FOV: 45 degrees. Fundus photo. 1932x1923:
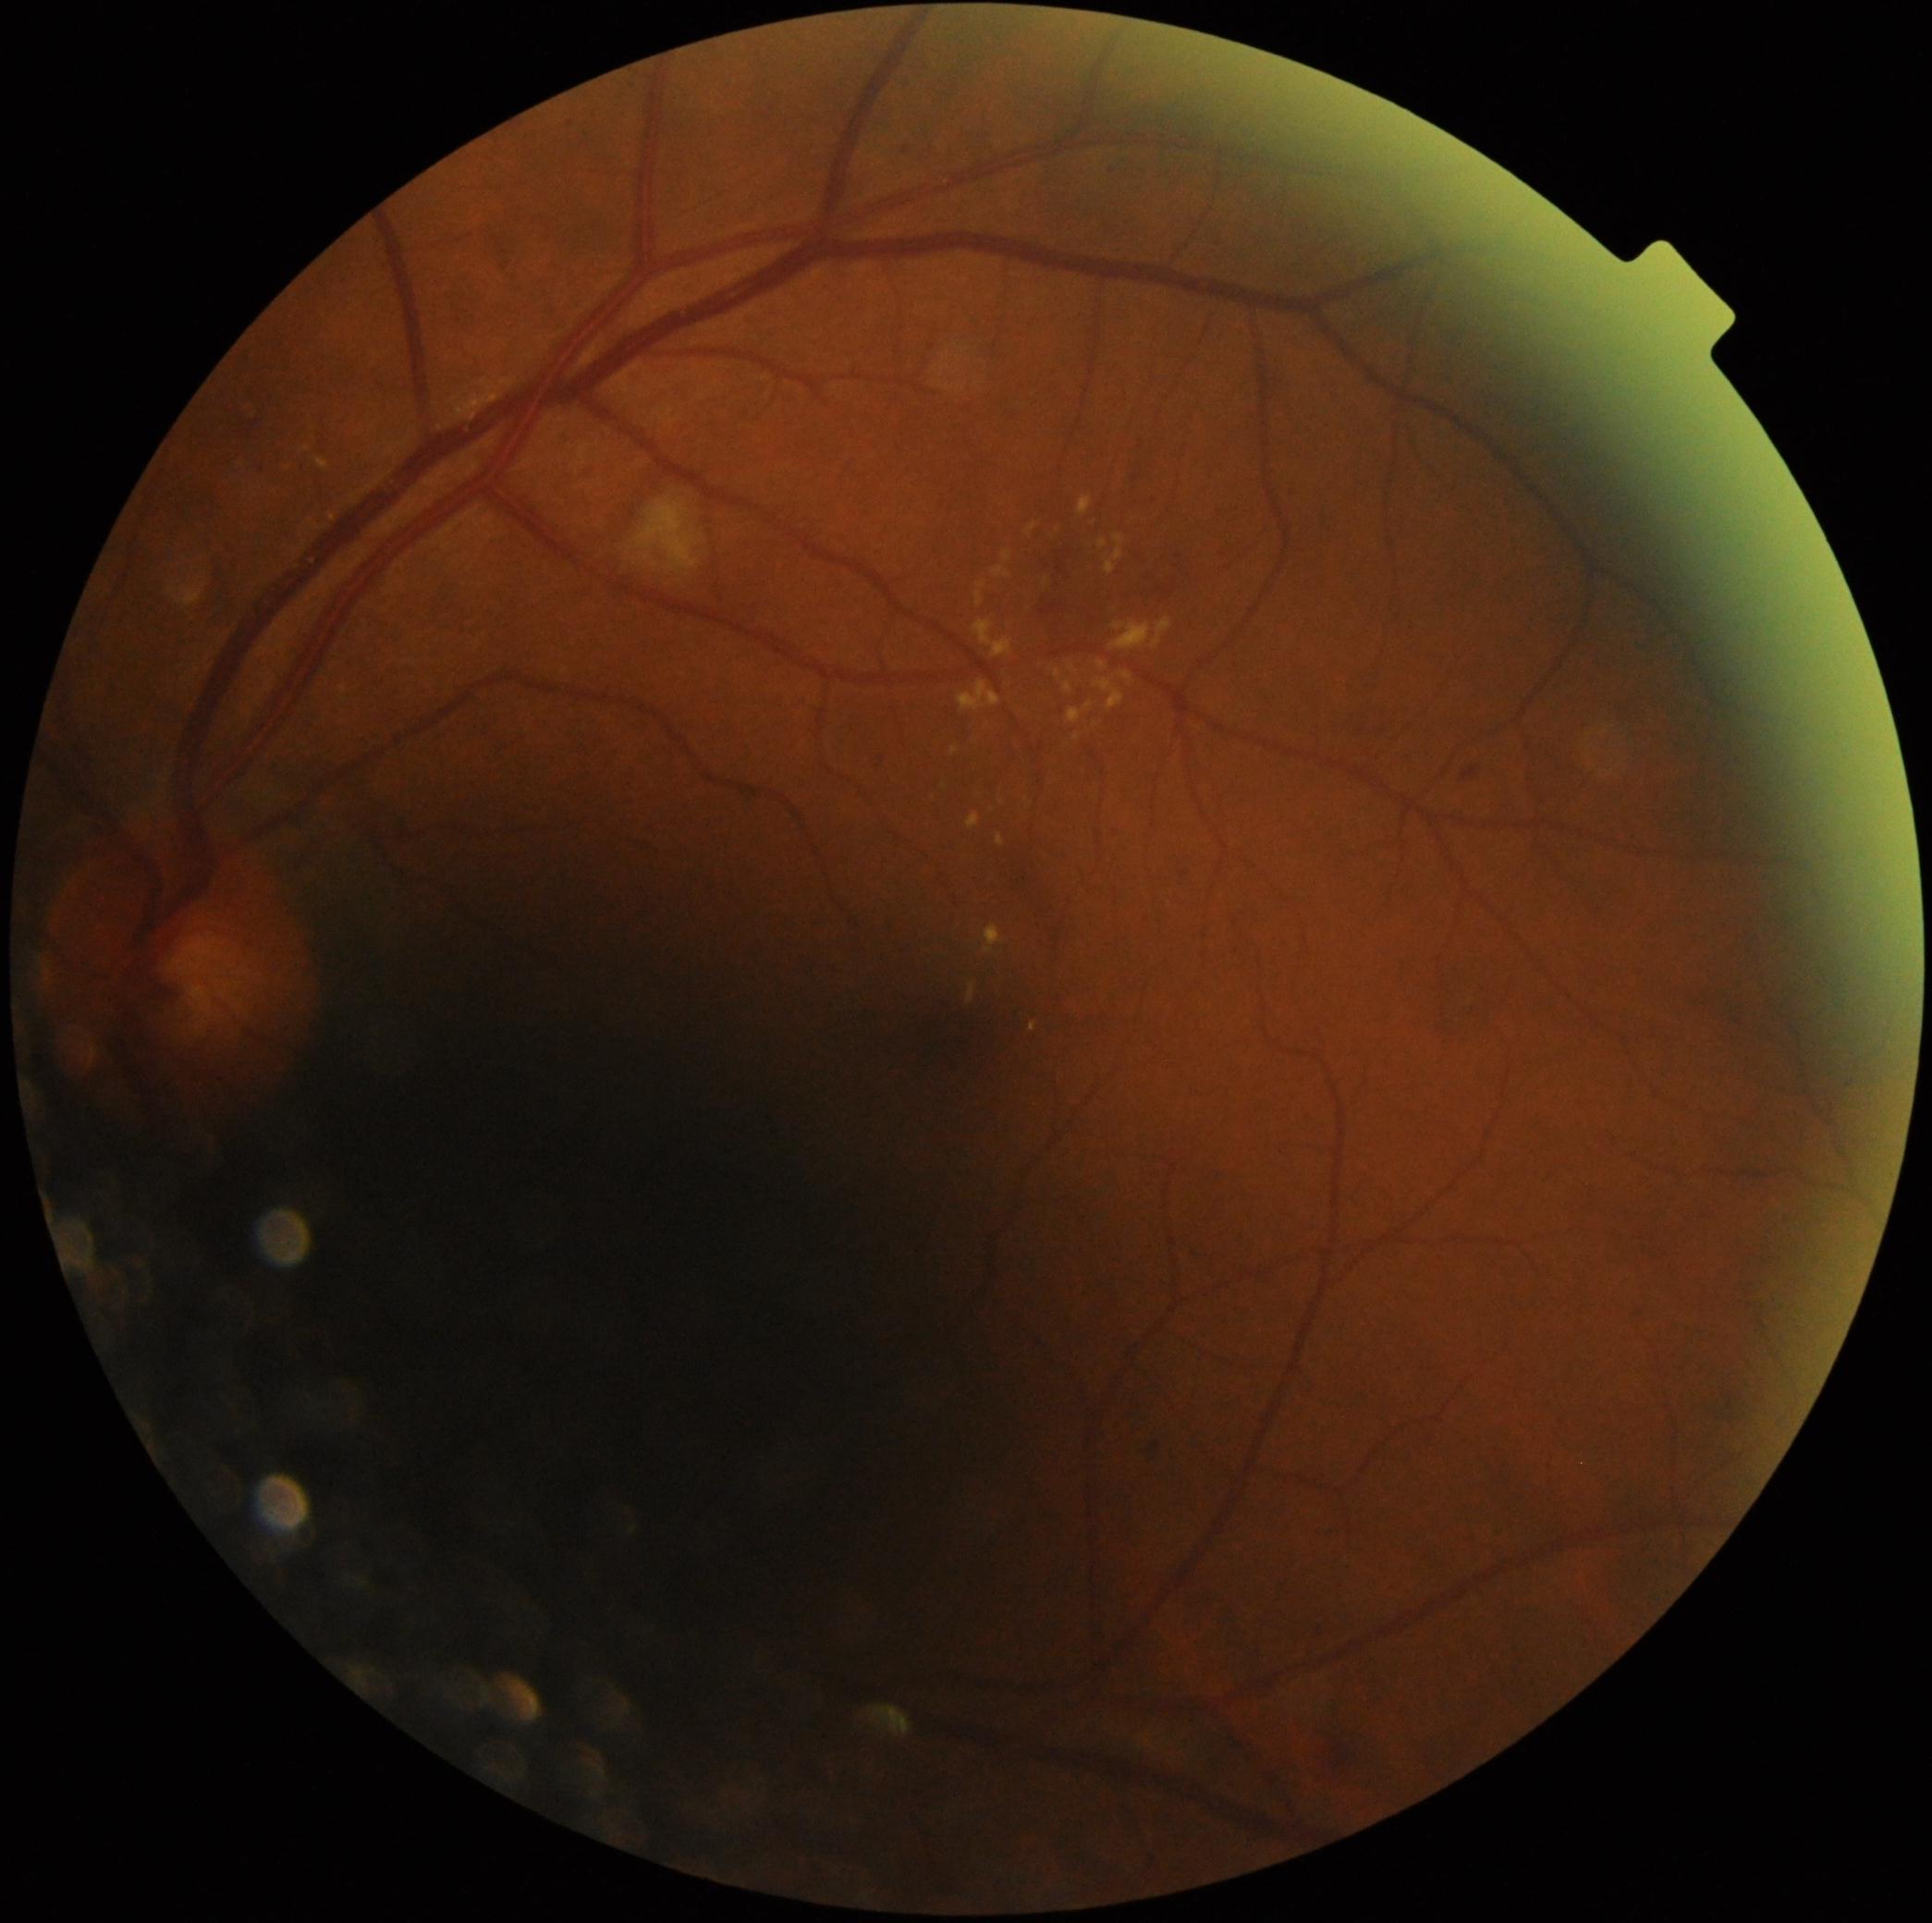
dr_grade: grade 2 (moderate NPDR) — more than just microaneurysms but less than severe NPDR
dr_category: non-proliferative diabetic retinopathy